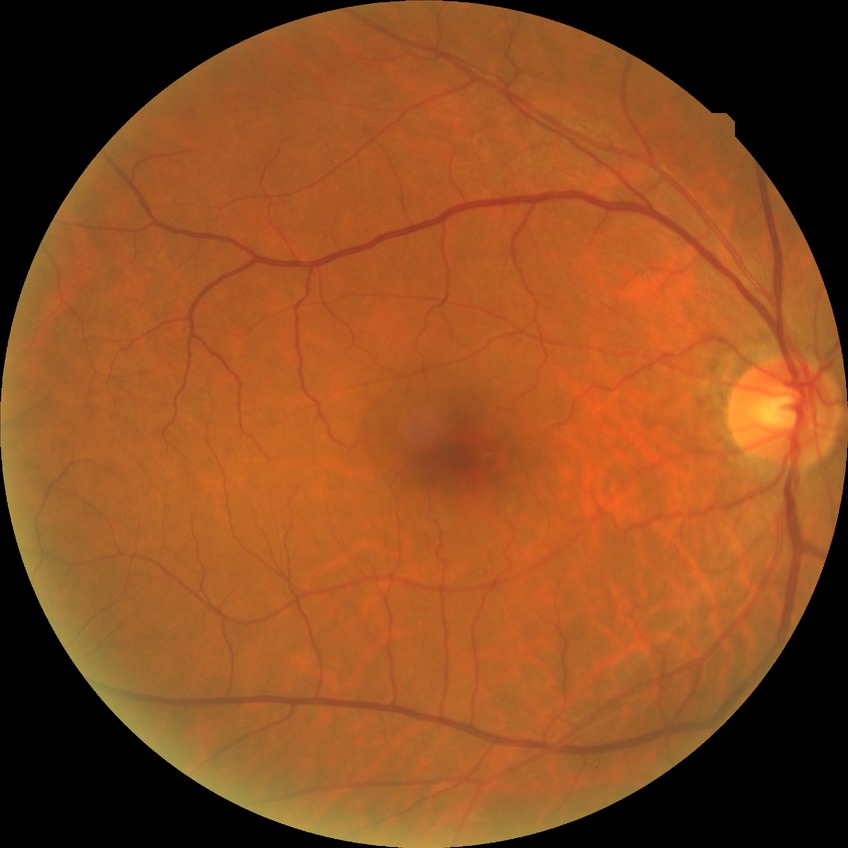 * diabetic retinopathy (DR) — NDR (no diabetic retinopathy)